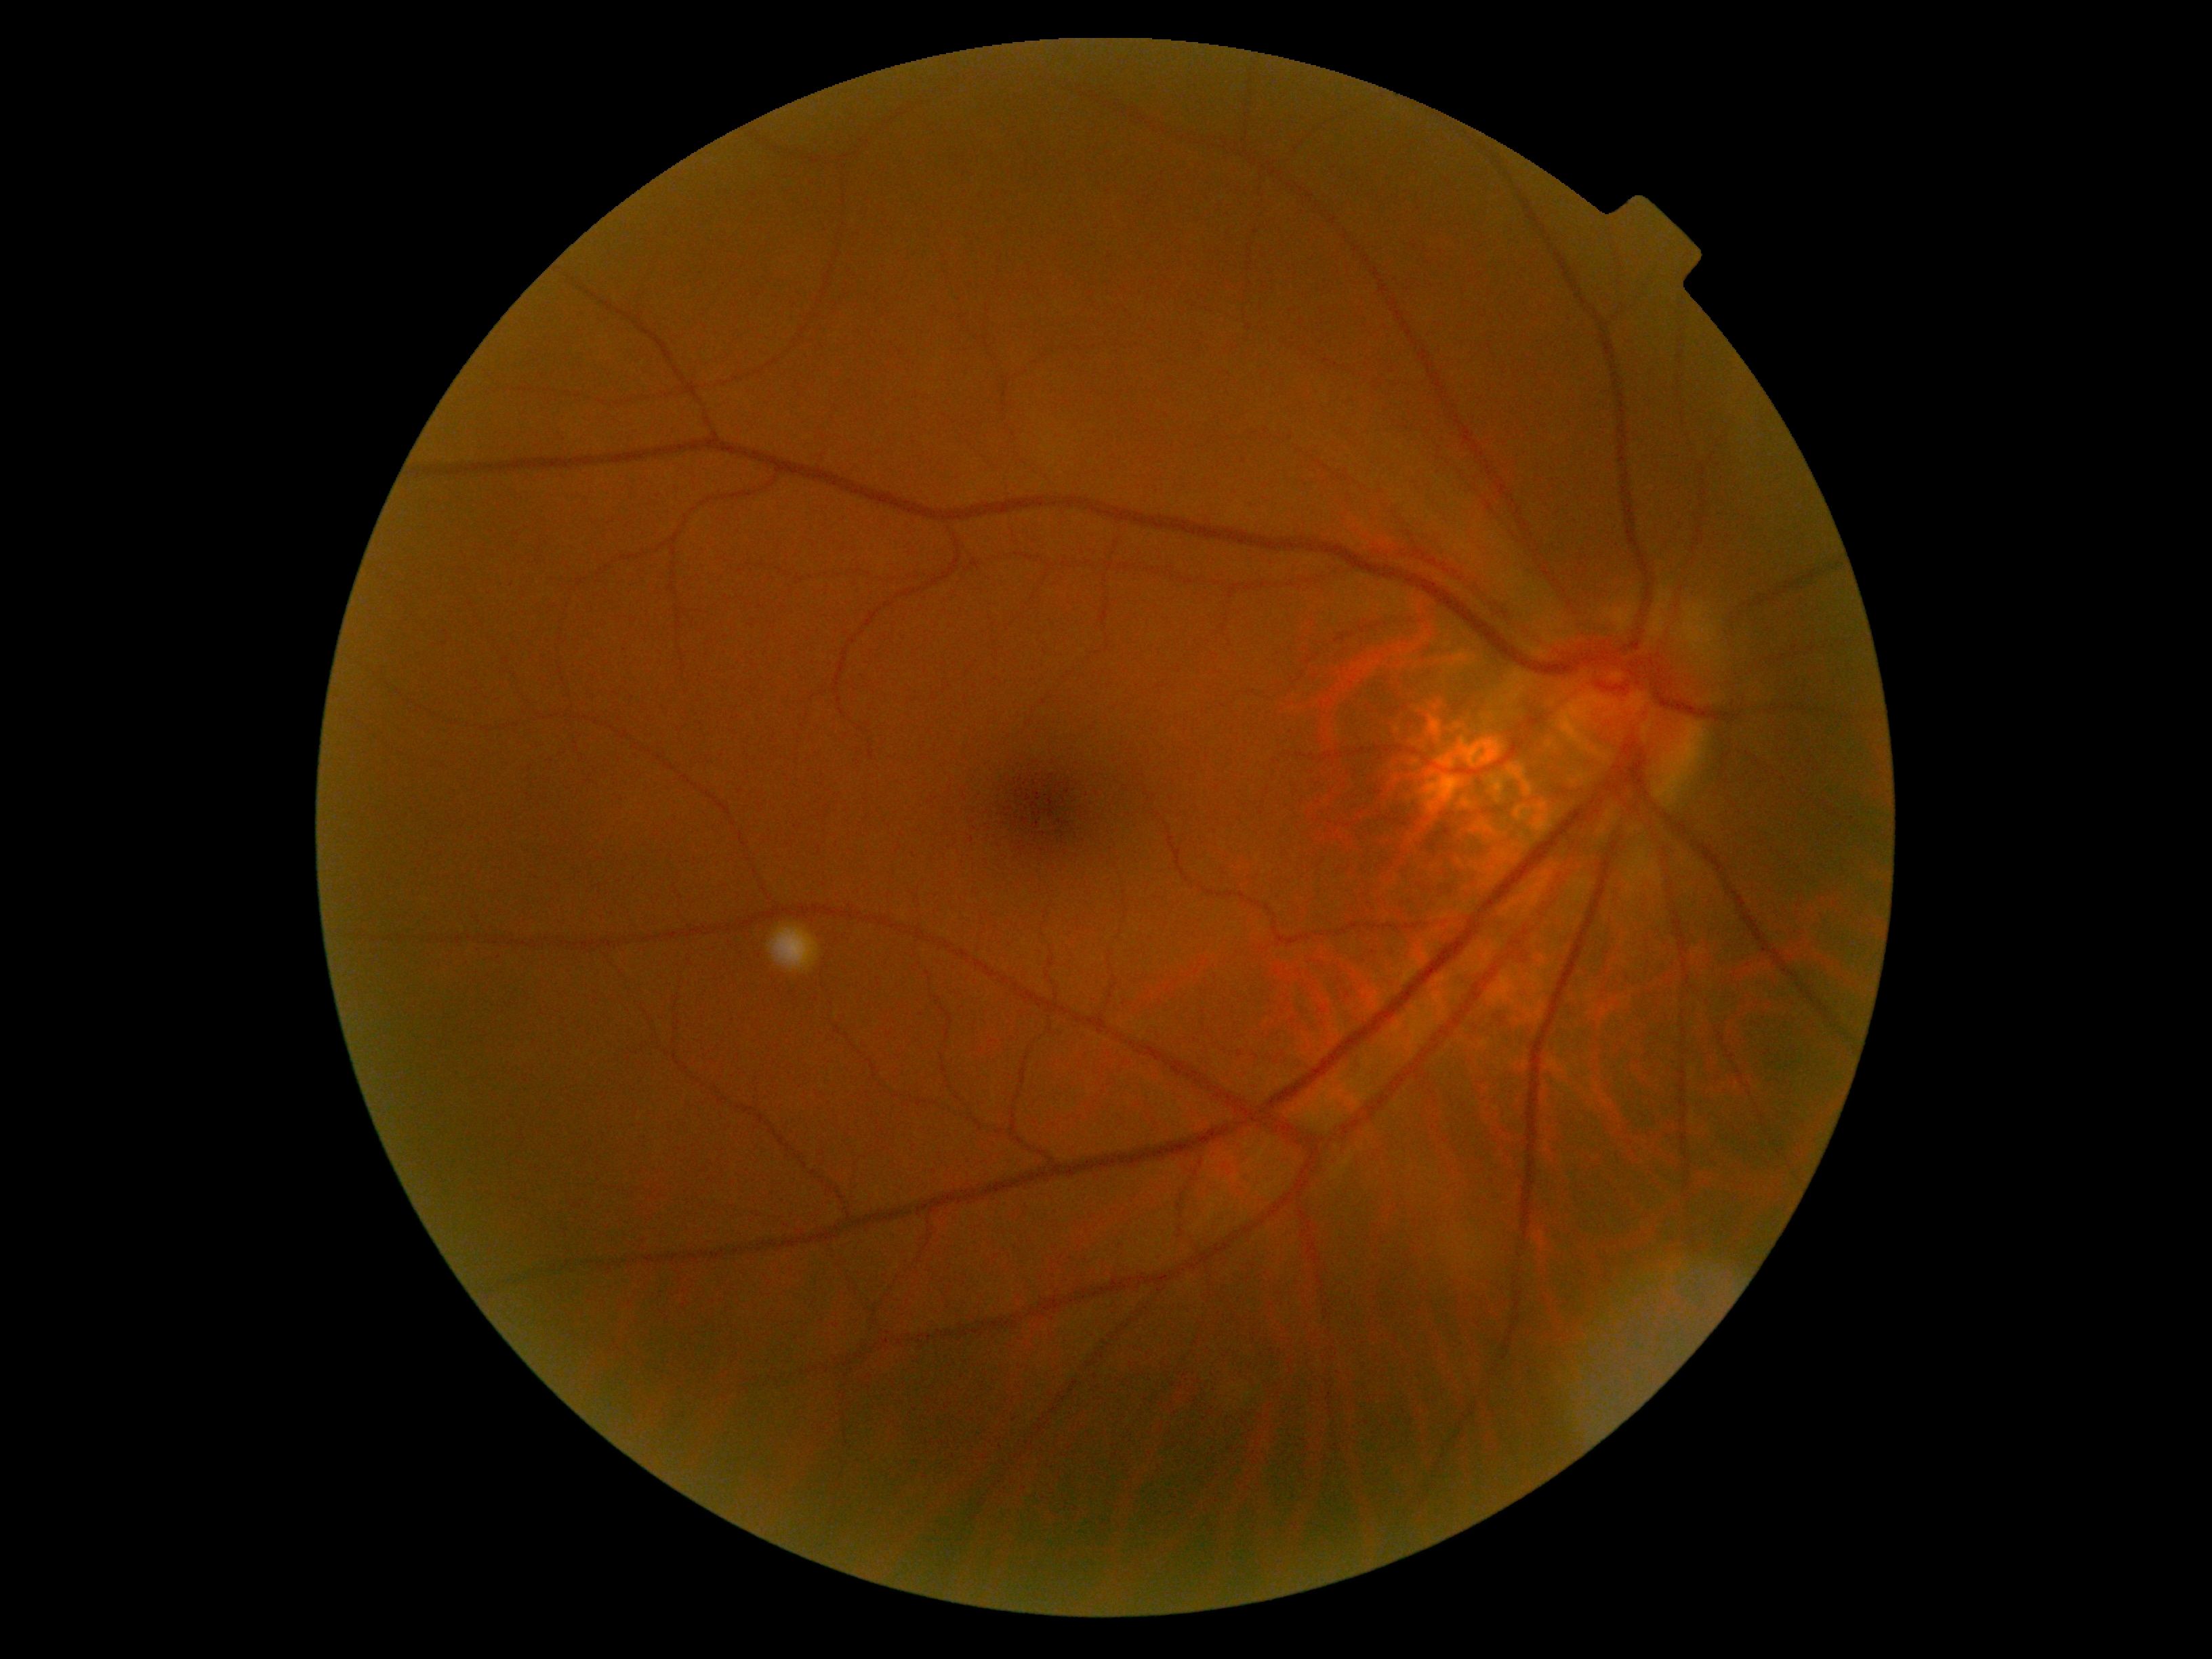
DR grade is no apparent retinopathy (0).